Nonmydriatic — 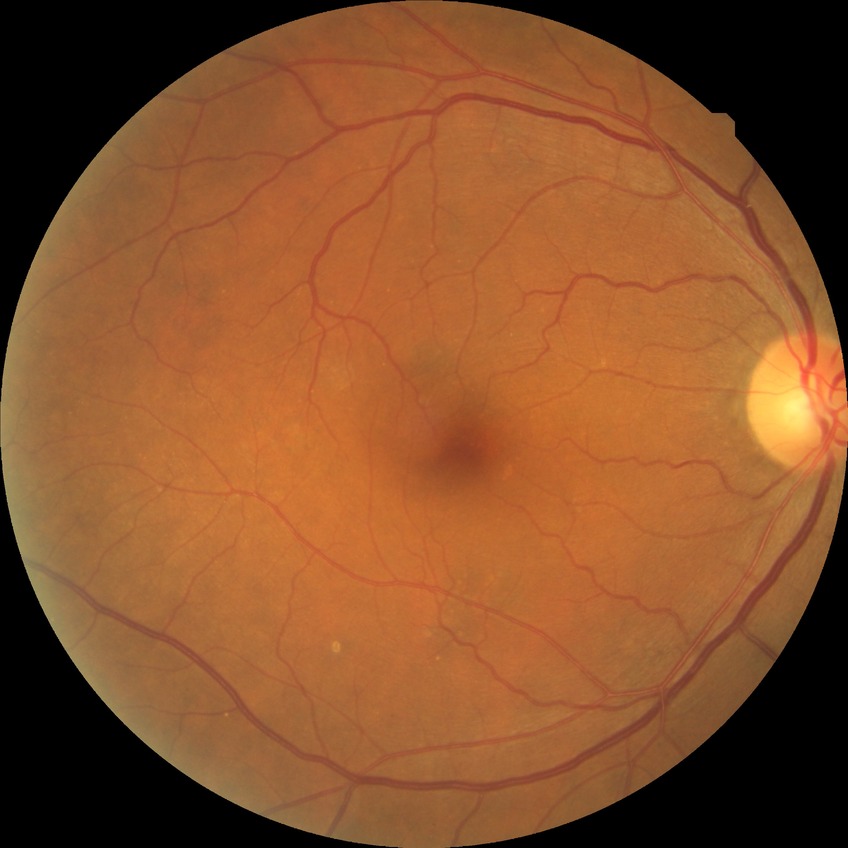 diabetic retinopathy (DR): NDR (no diabetic retinopathy).